2212 x 1659 pixels; CFP; 45° field of view: 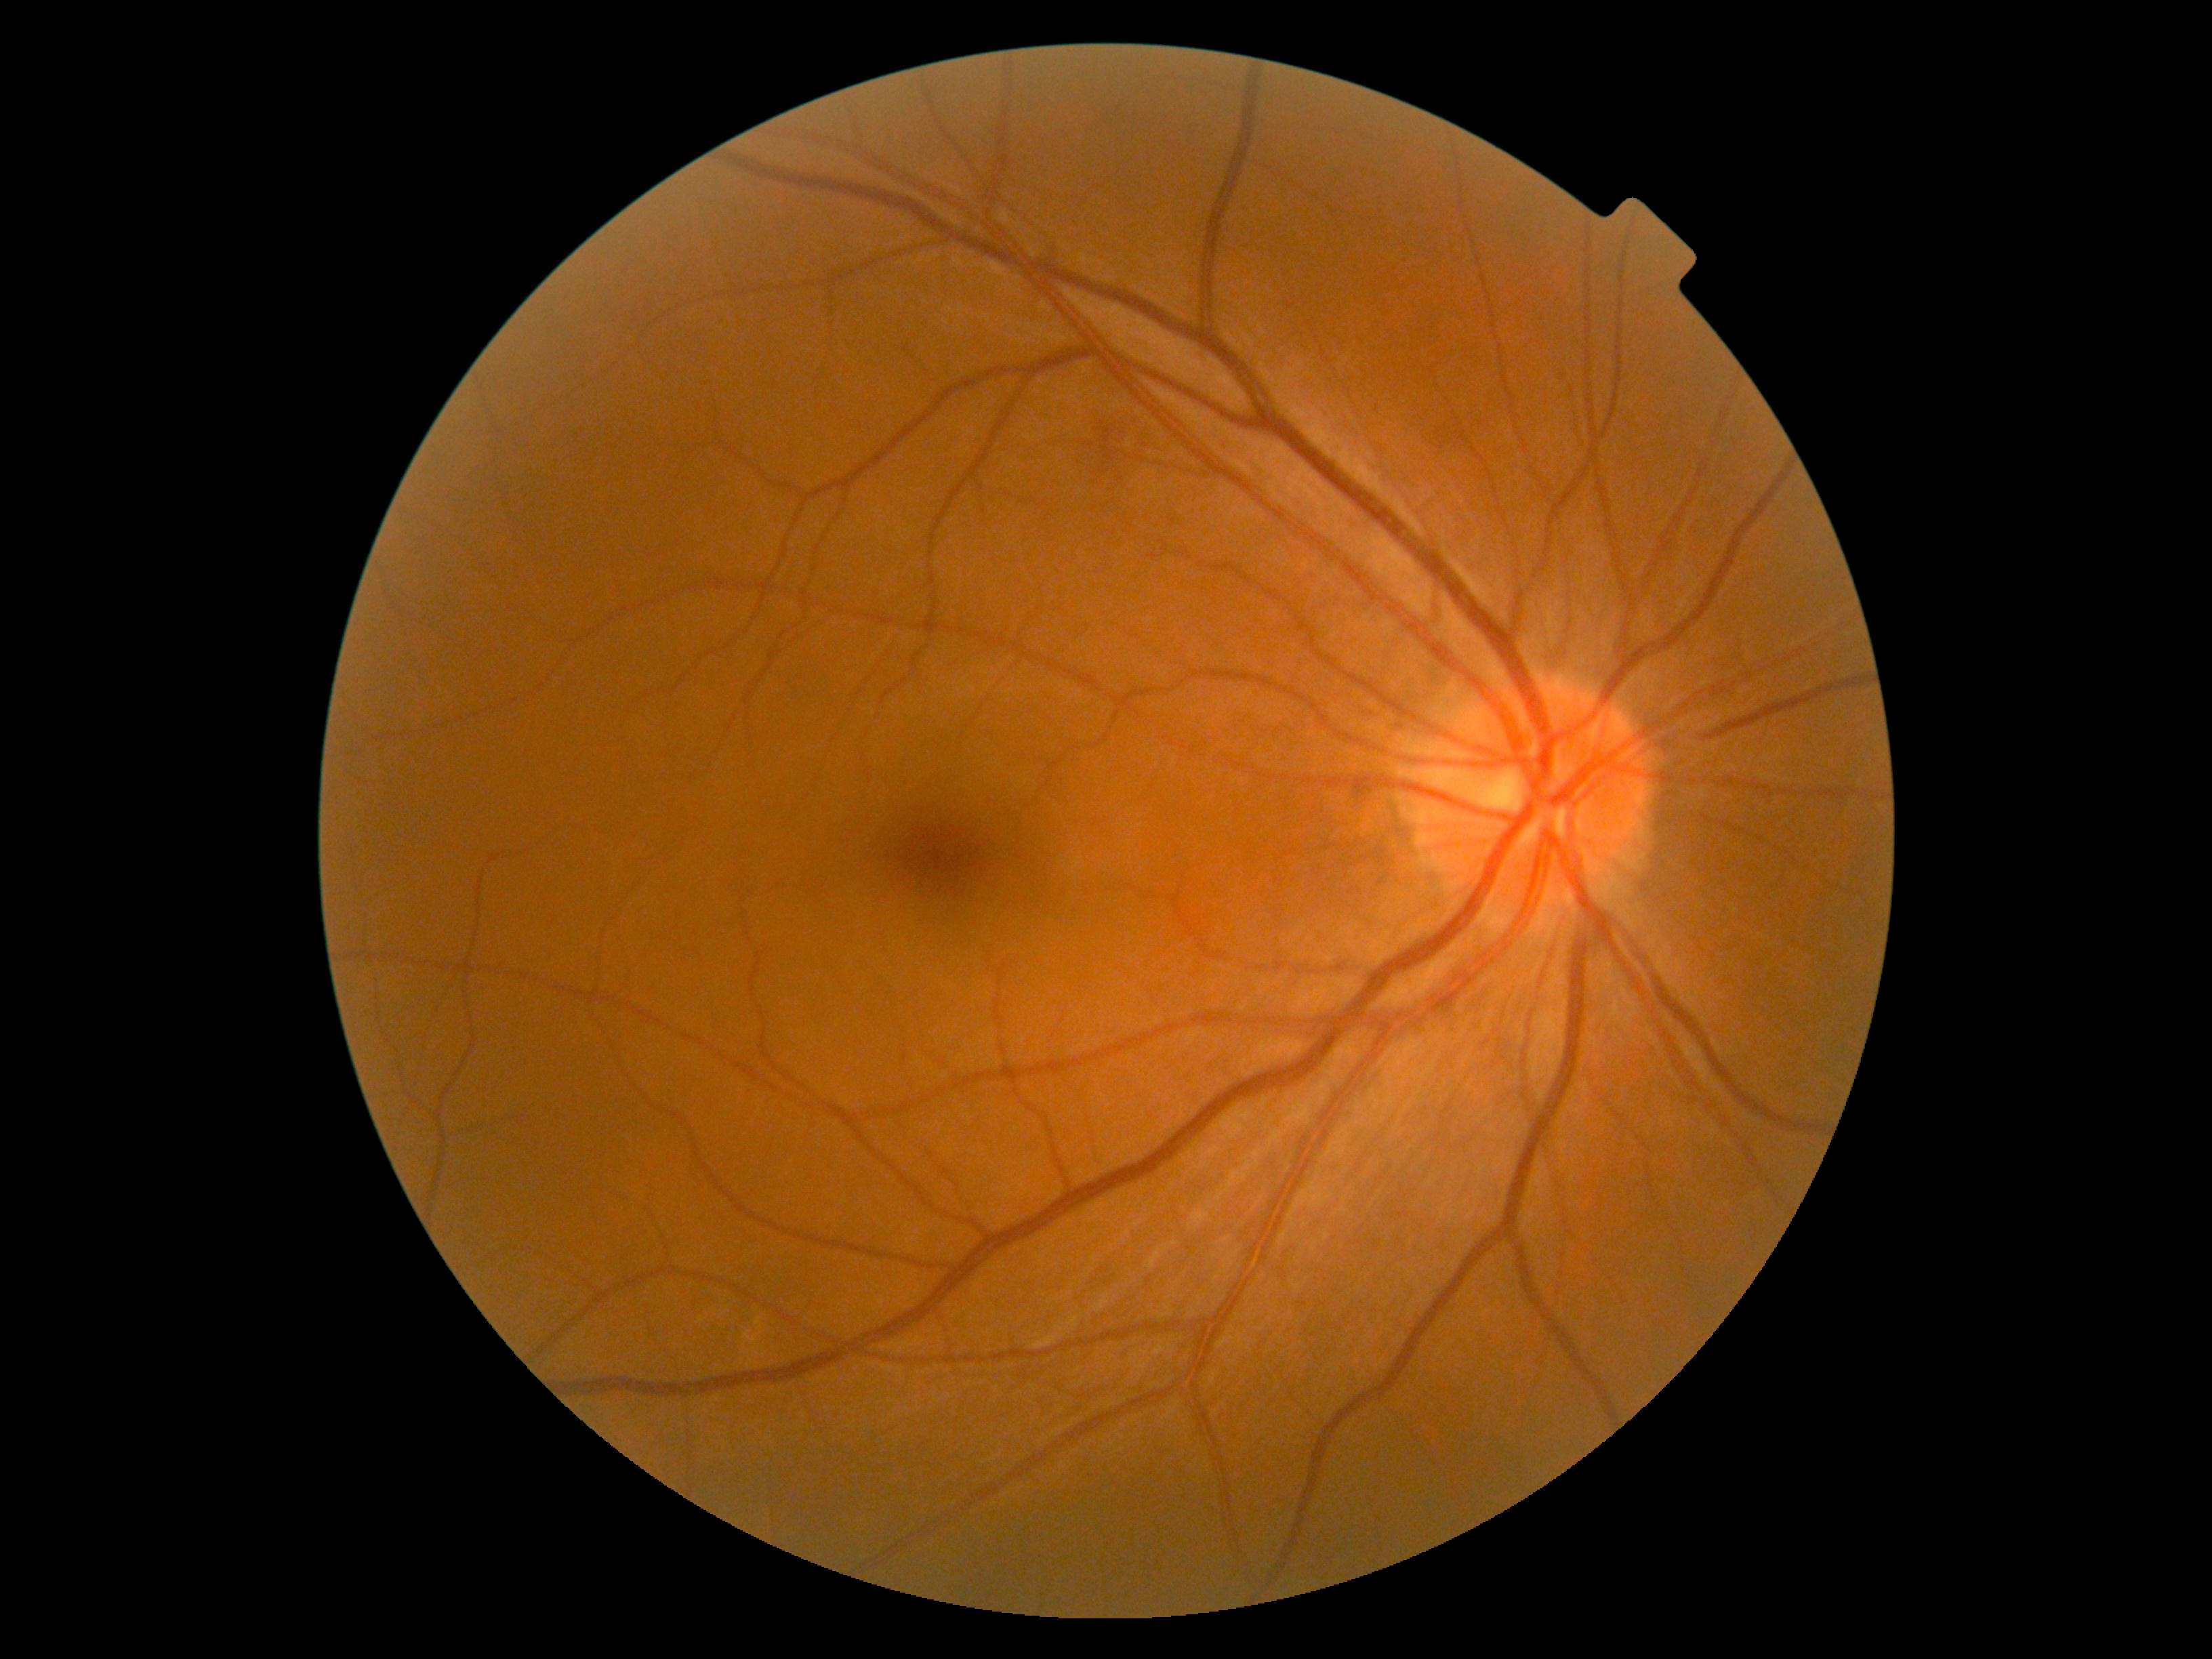 DR: moderate NPDR (grade 2) — more than just microaneurysms but less than severe NPDR